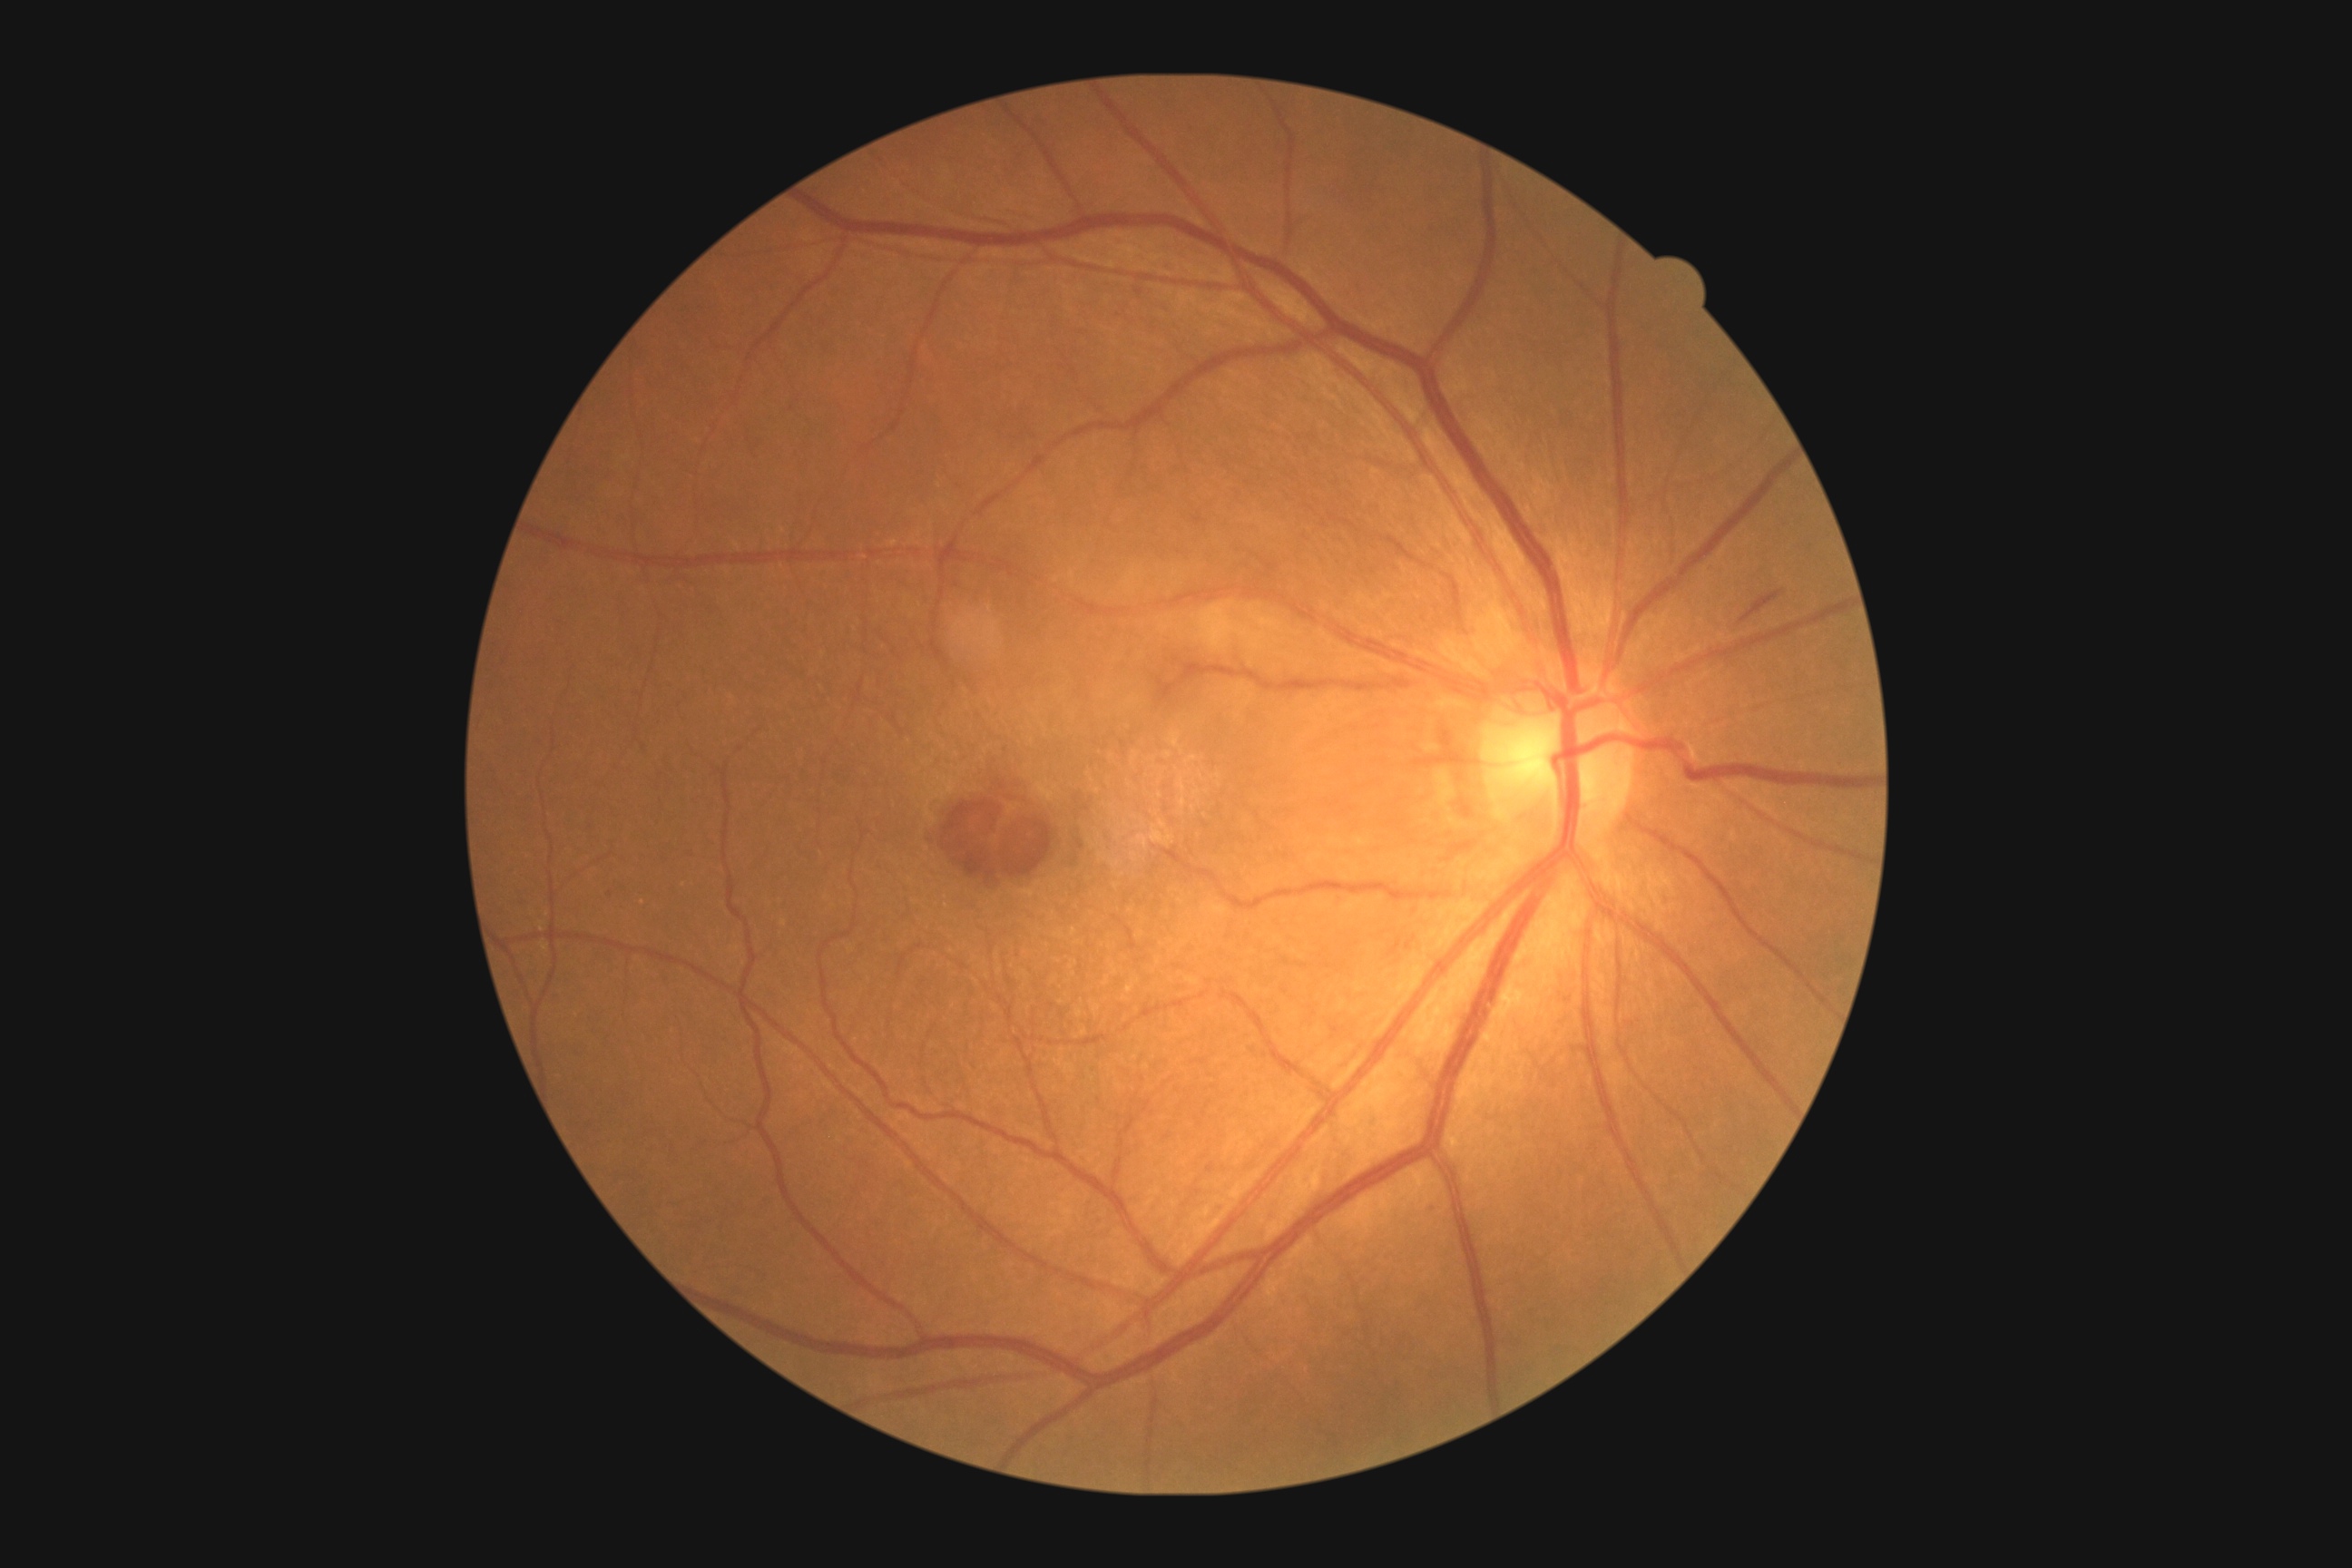

Findings:
- DR class: non-proliferative diabetic retinopathy
- diabetic retinopathy (DR): moderate NPDR (grade 2)